IOP: 29 mmHg; axial length (AL) 22.63 mm; 73 years old
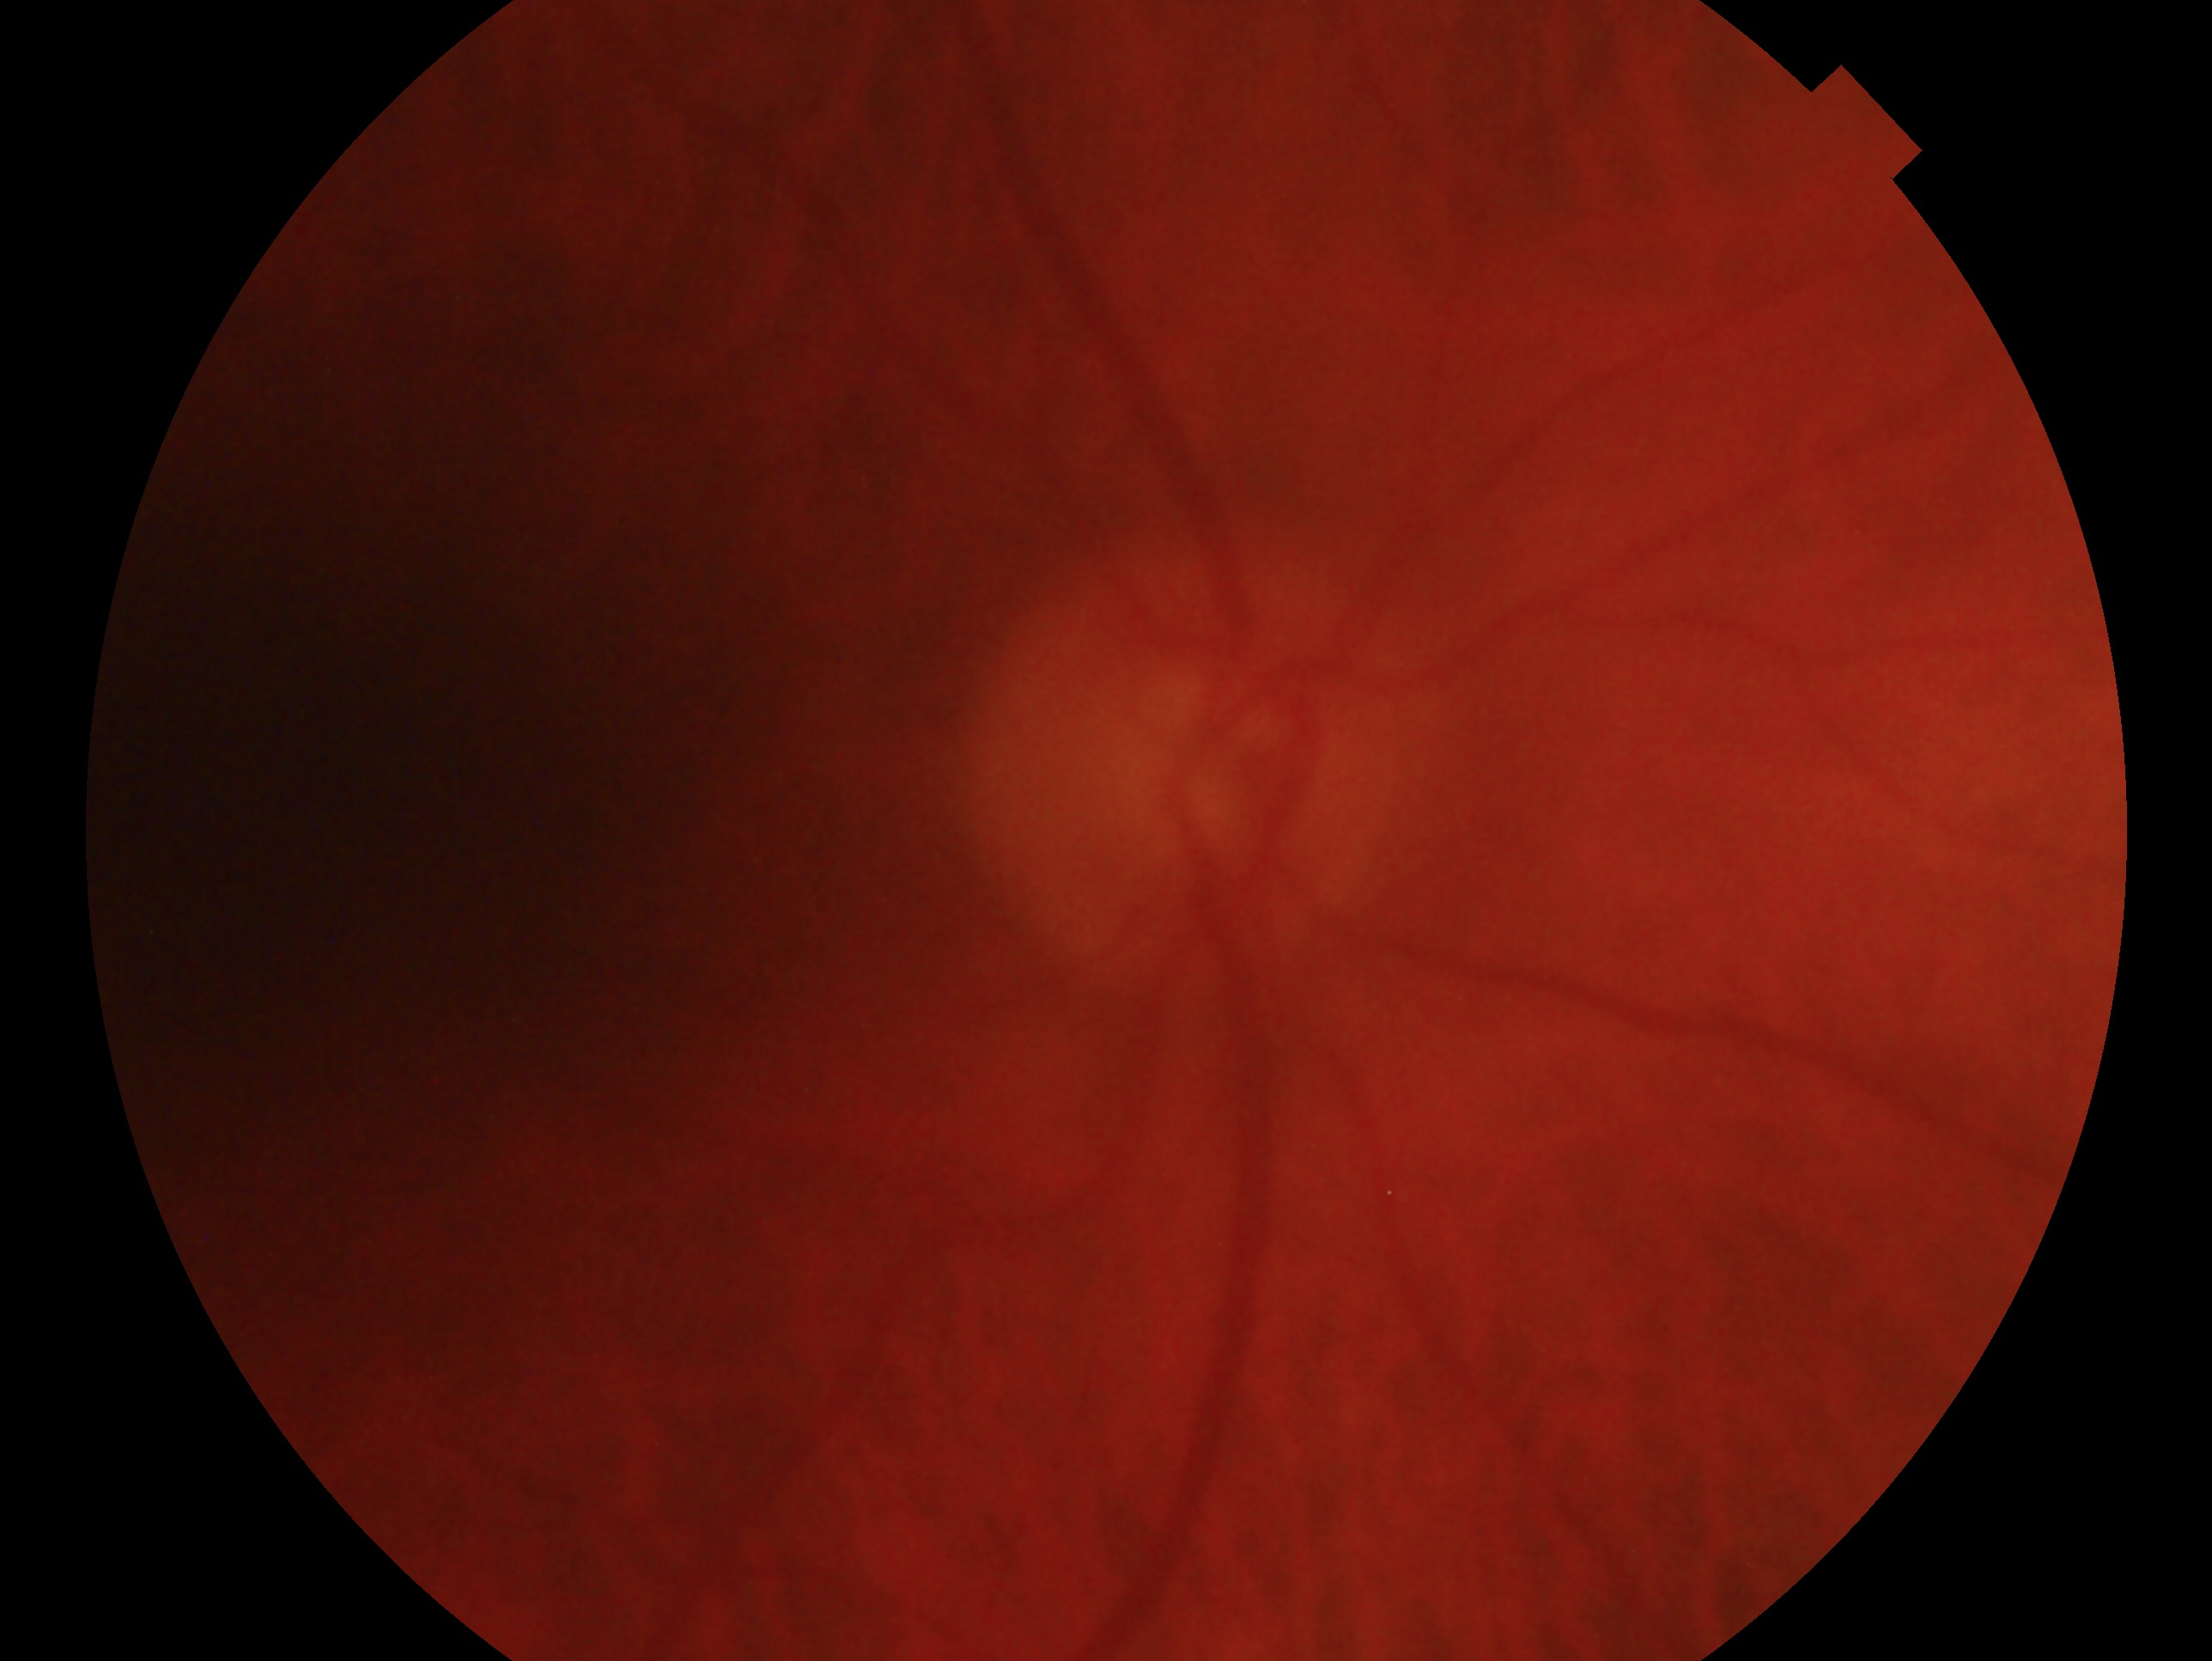

{
  "eye": "oculus dexter",
  "glaucoma_dx": "consistent with glaucoma — clinically confirmed glaucoma with characteristic optic nerve damage"
}